Graded on the modified Davis scale: 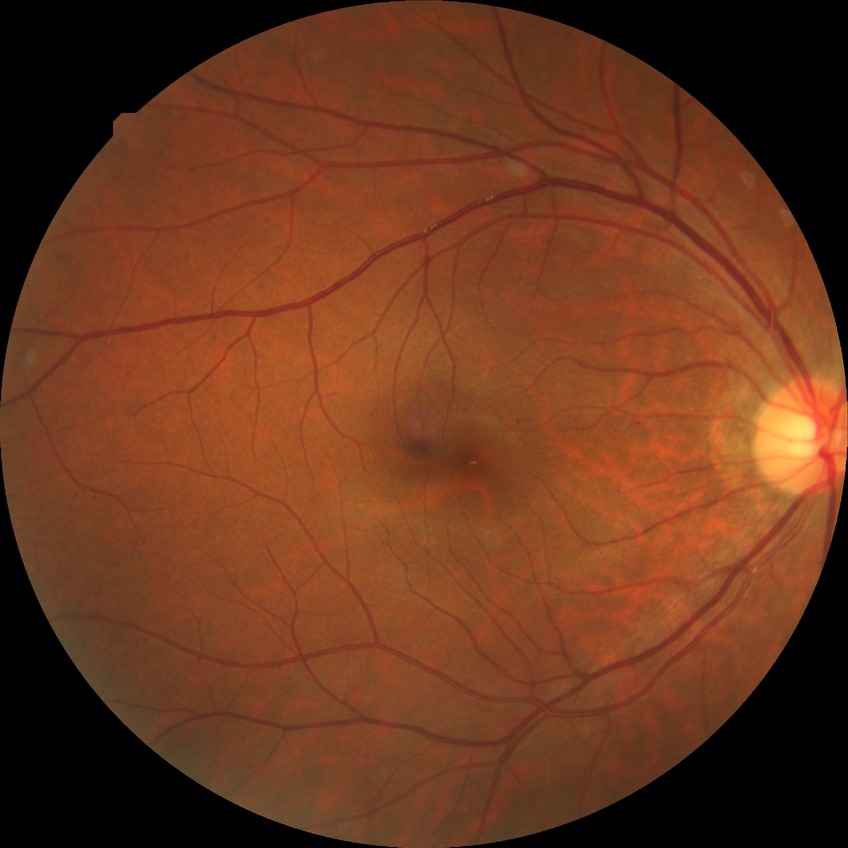 diabetic retinopathy (DR)@SDR (simple diabetic retinopathy).